50-degree field of view; macula-centered:
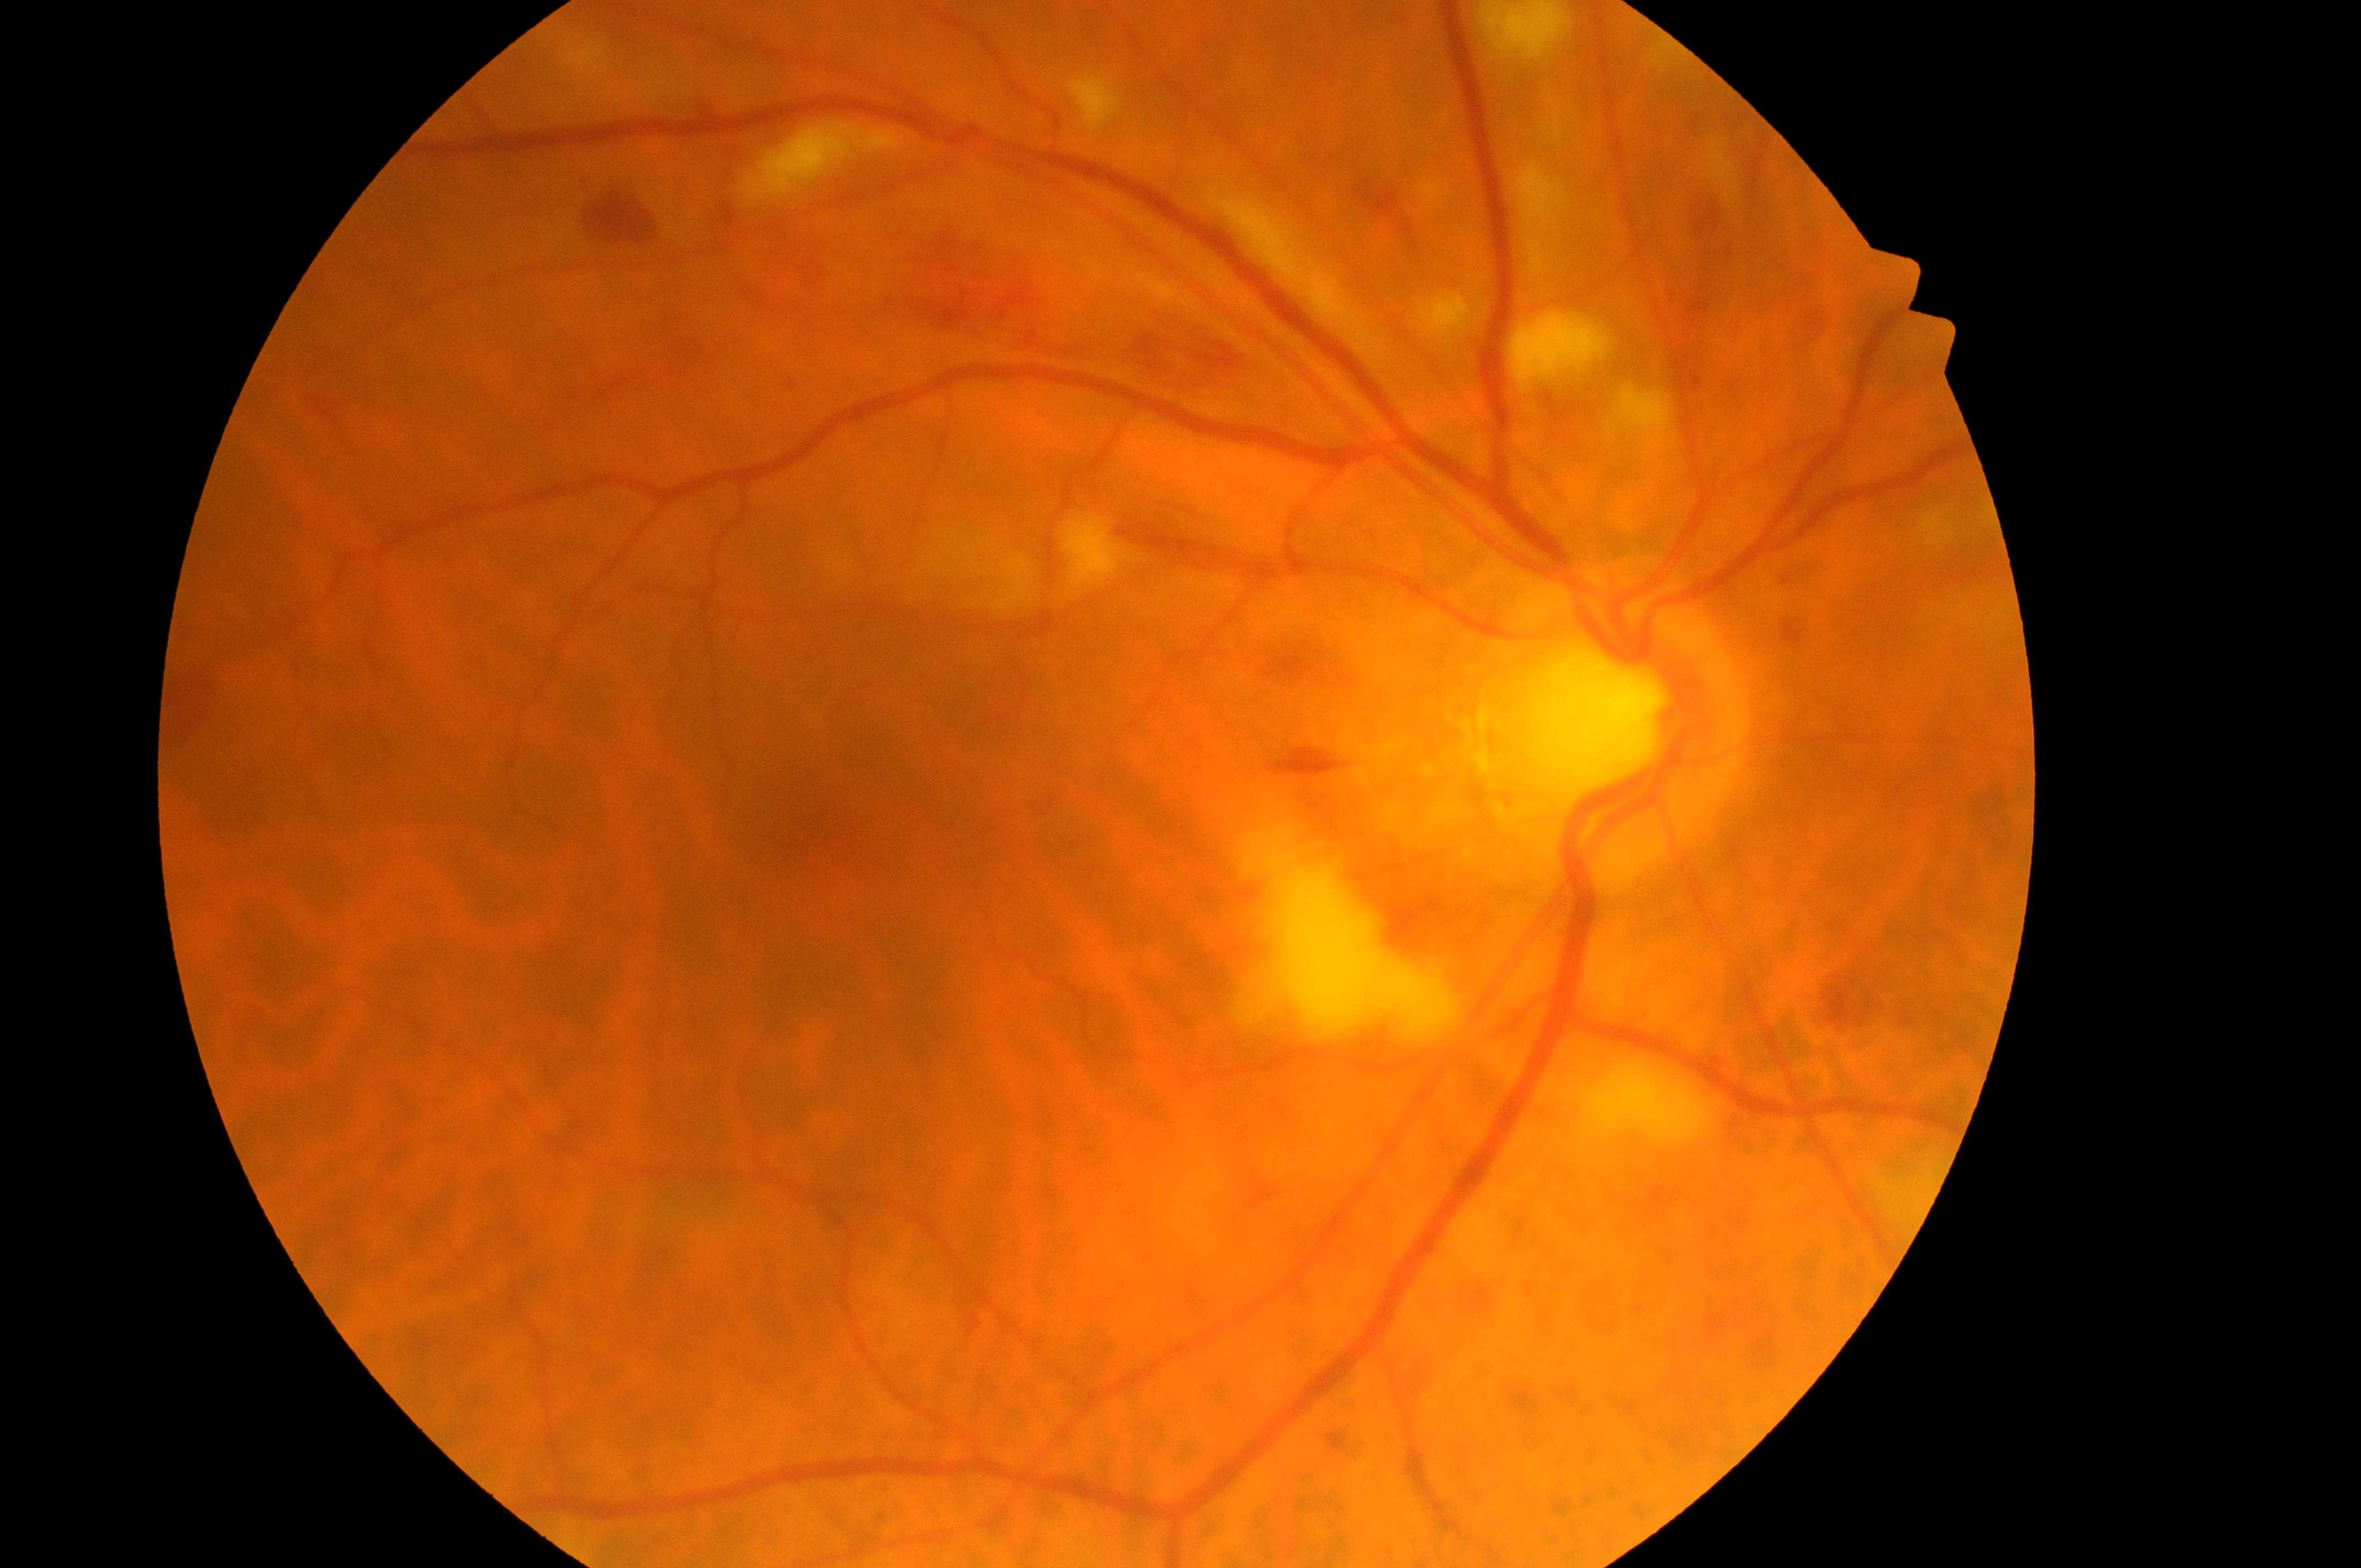

This is the right eye. The retinopathy is classified as non-proliferative diabetic retinopathy. DME is no risk (grade 0). The fovea is at (x: 837, y: 831). Optic disc: (x: 1607, y: 734). DR severity: moderate NPDR (grade 2).